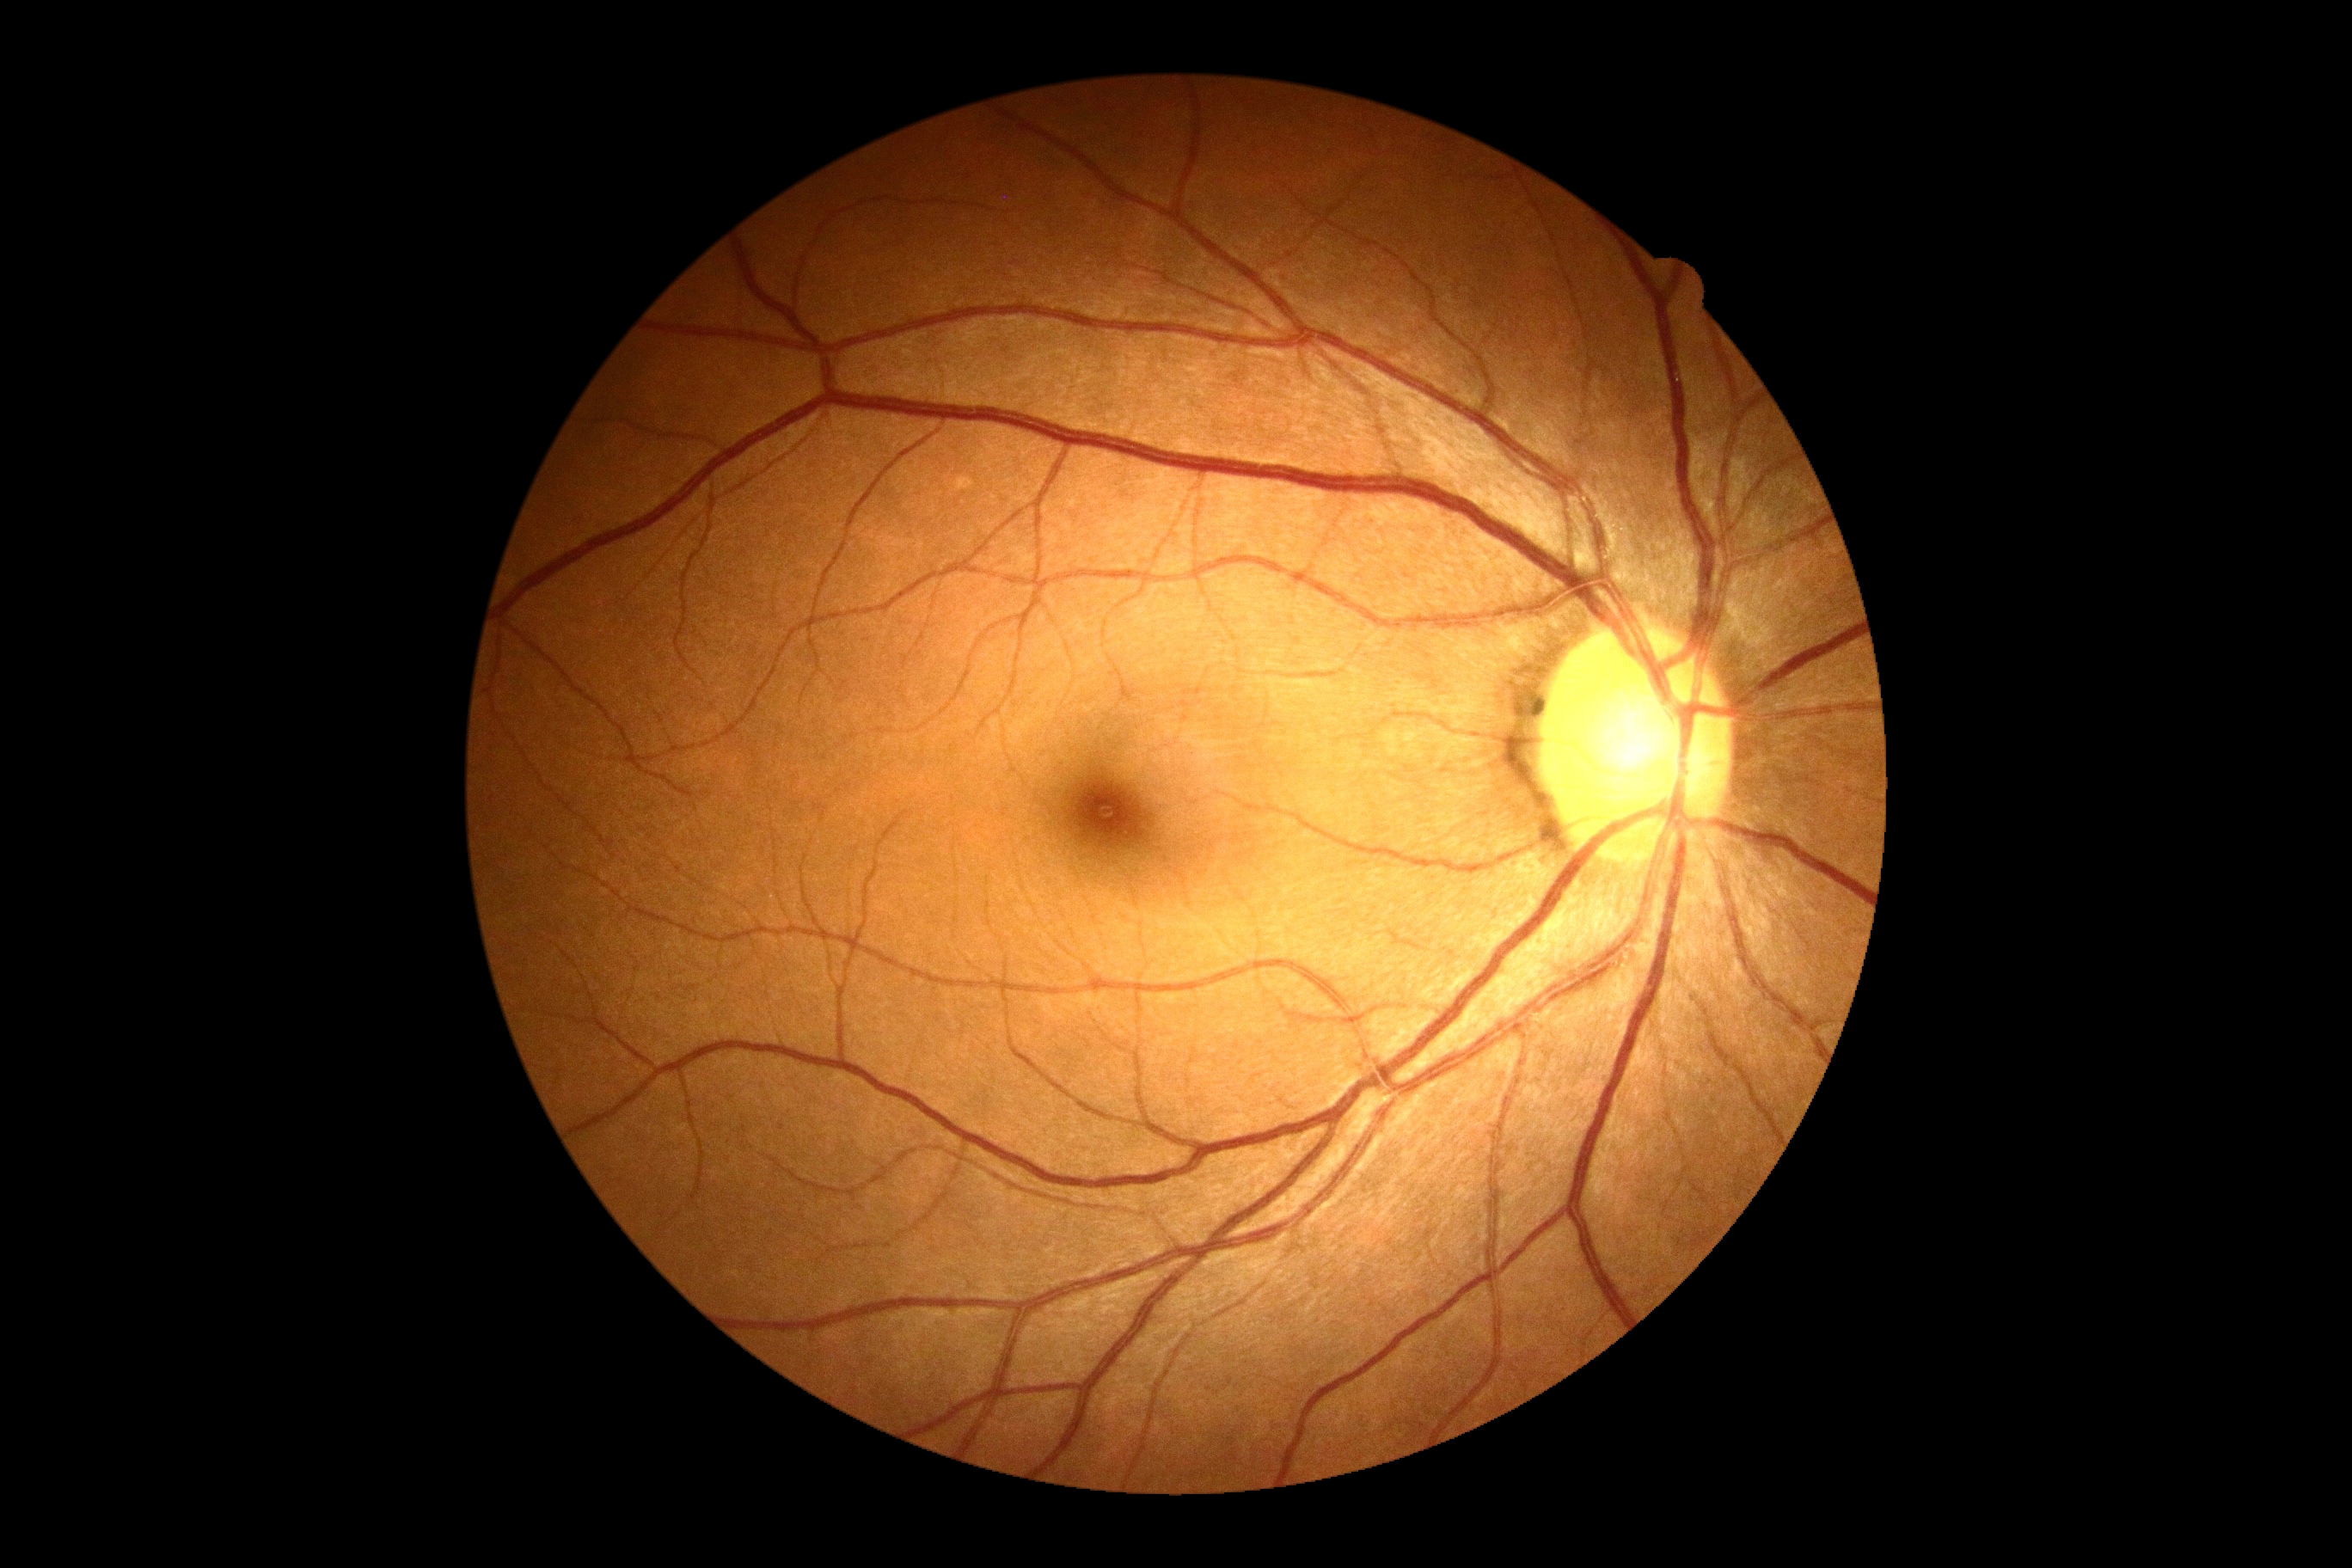 Diabetic retinopathy (DR) is grade 0 (no apparent retinopathy).
No signs of diabetic retinopathy.